CFP · 45-degree field of view: 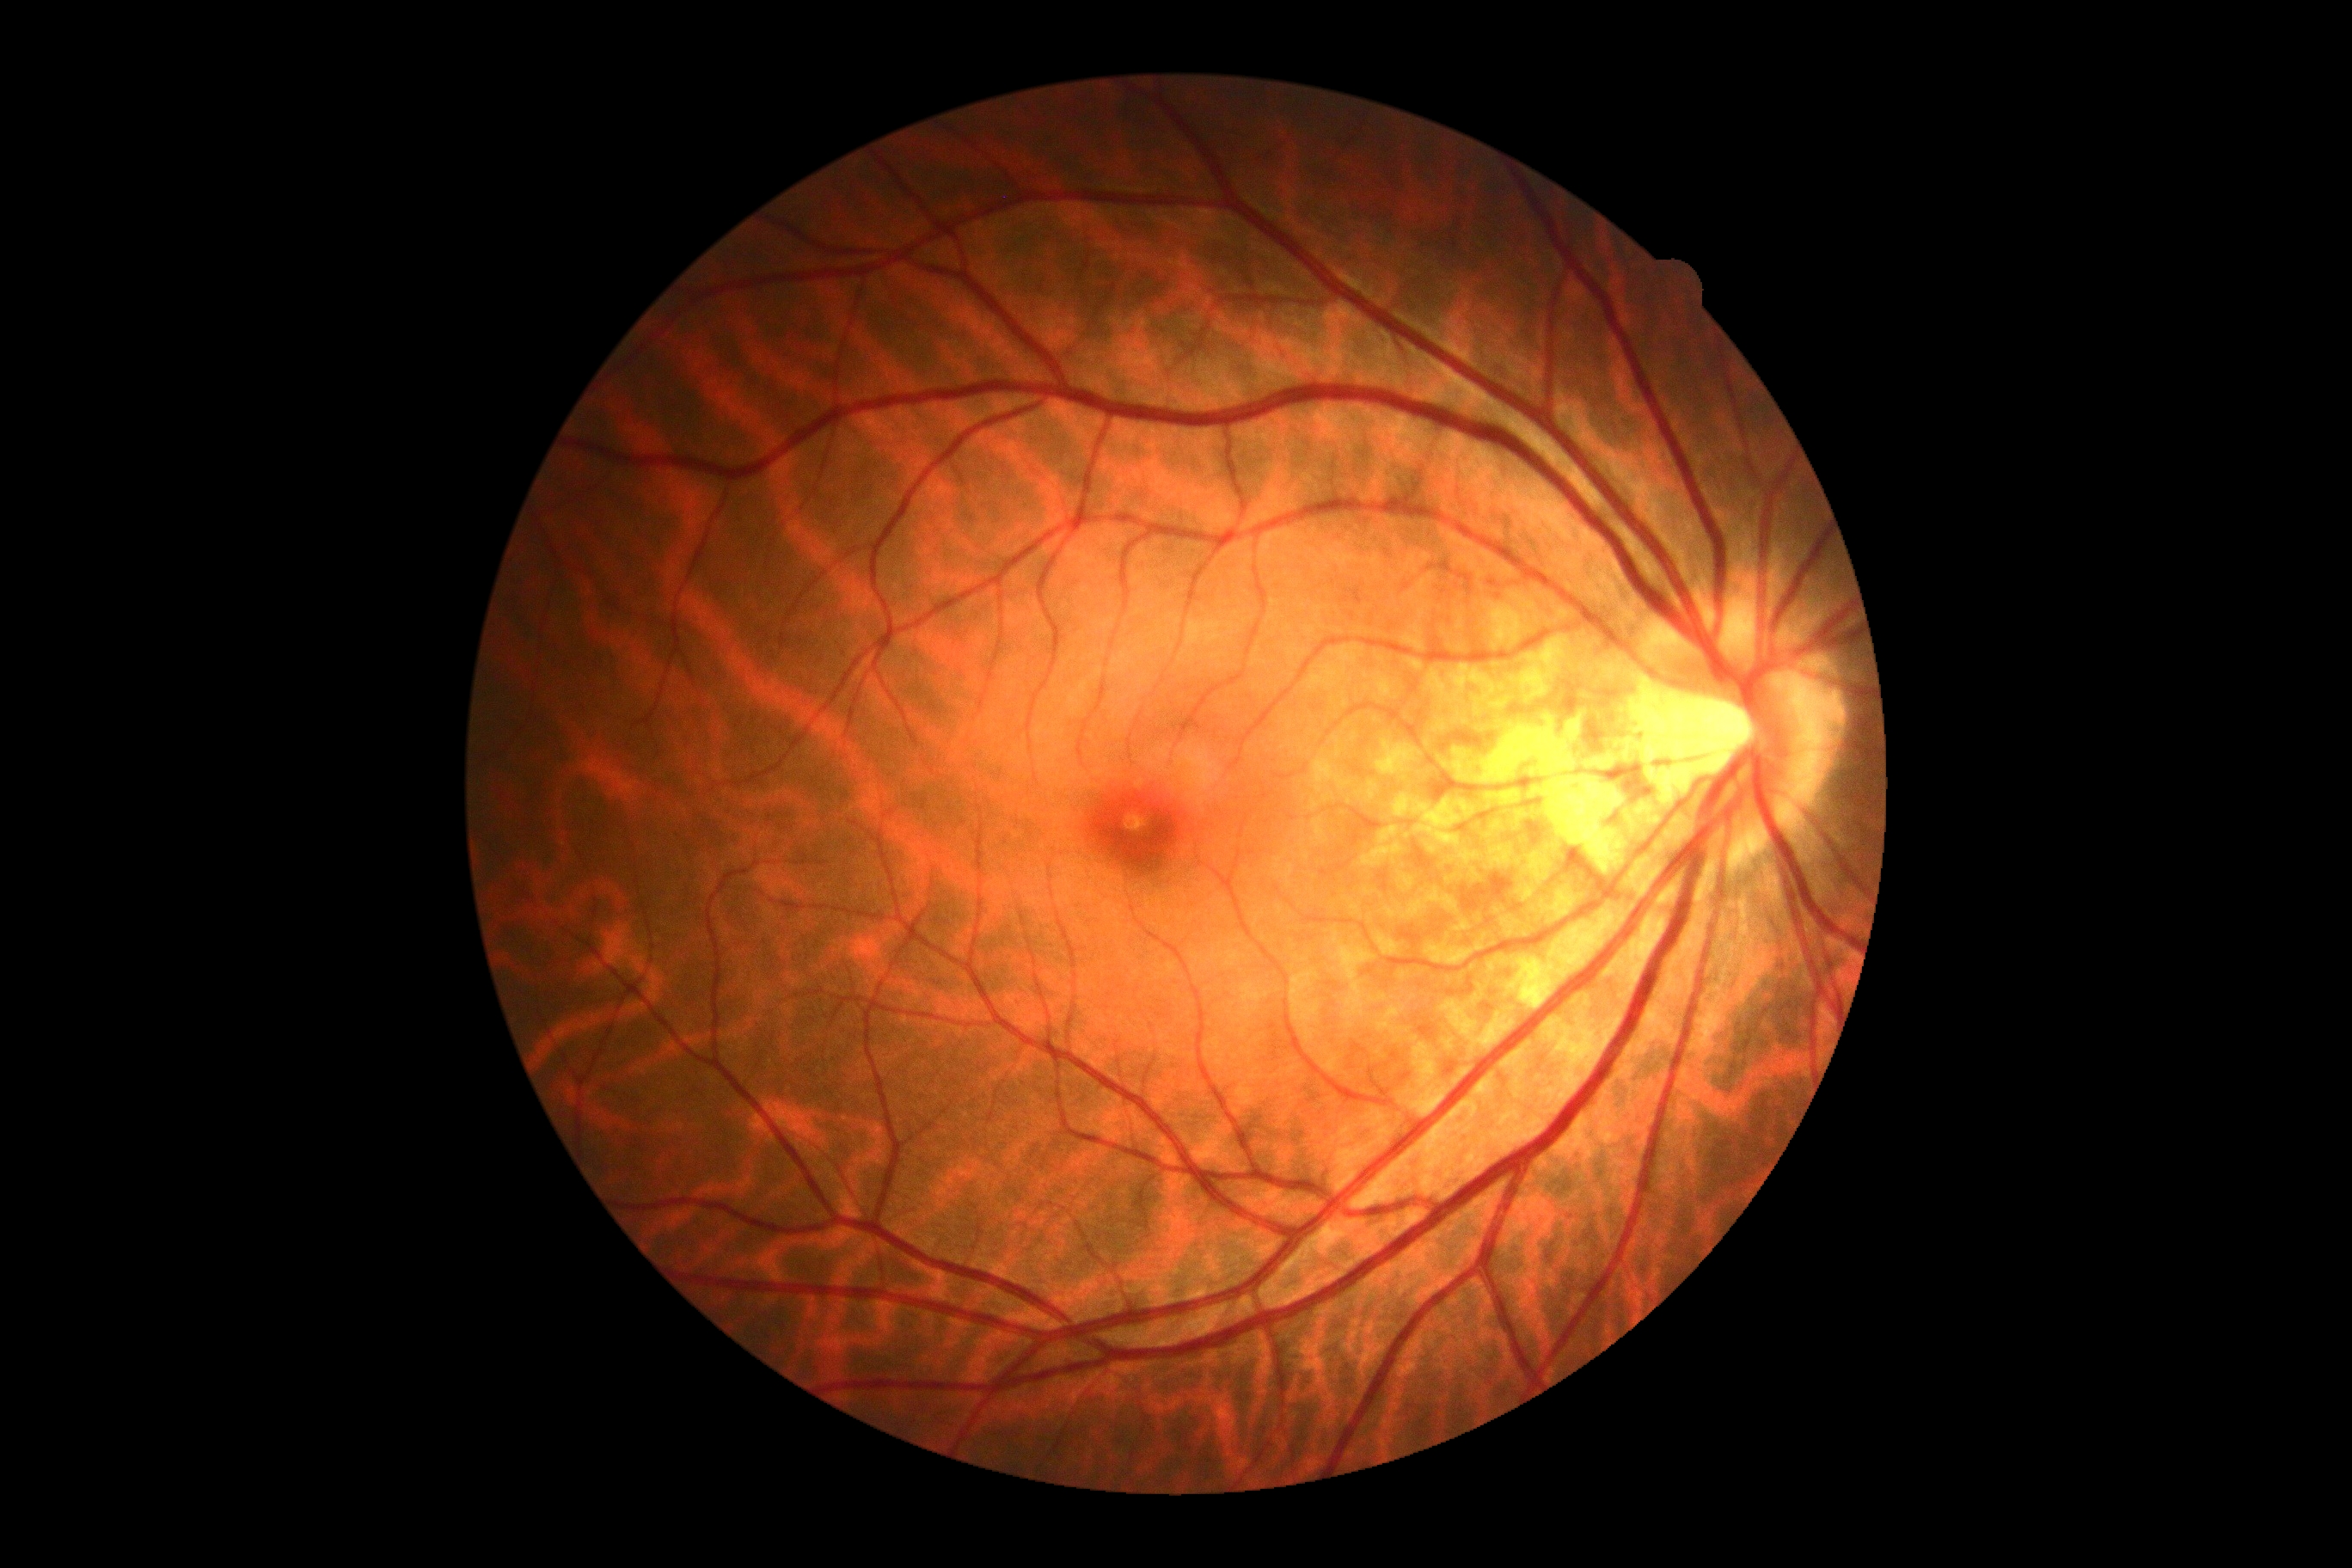 Diabetic retinopathy (DR): no apparent retinopathy (grade 0).